2352 x 1568 pixels · CFP.
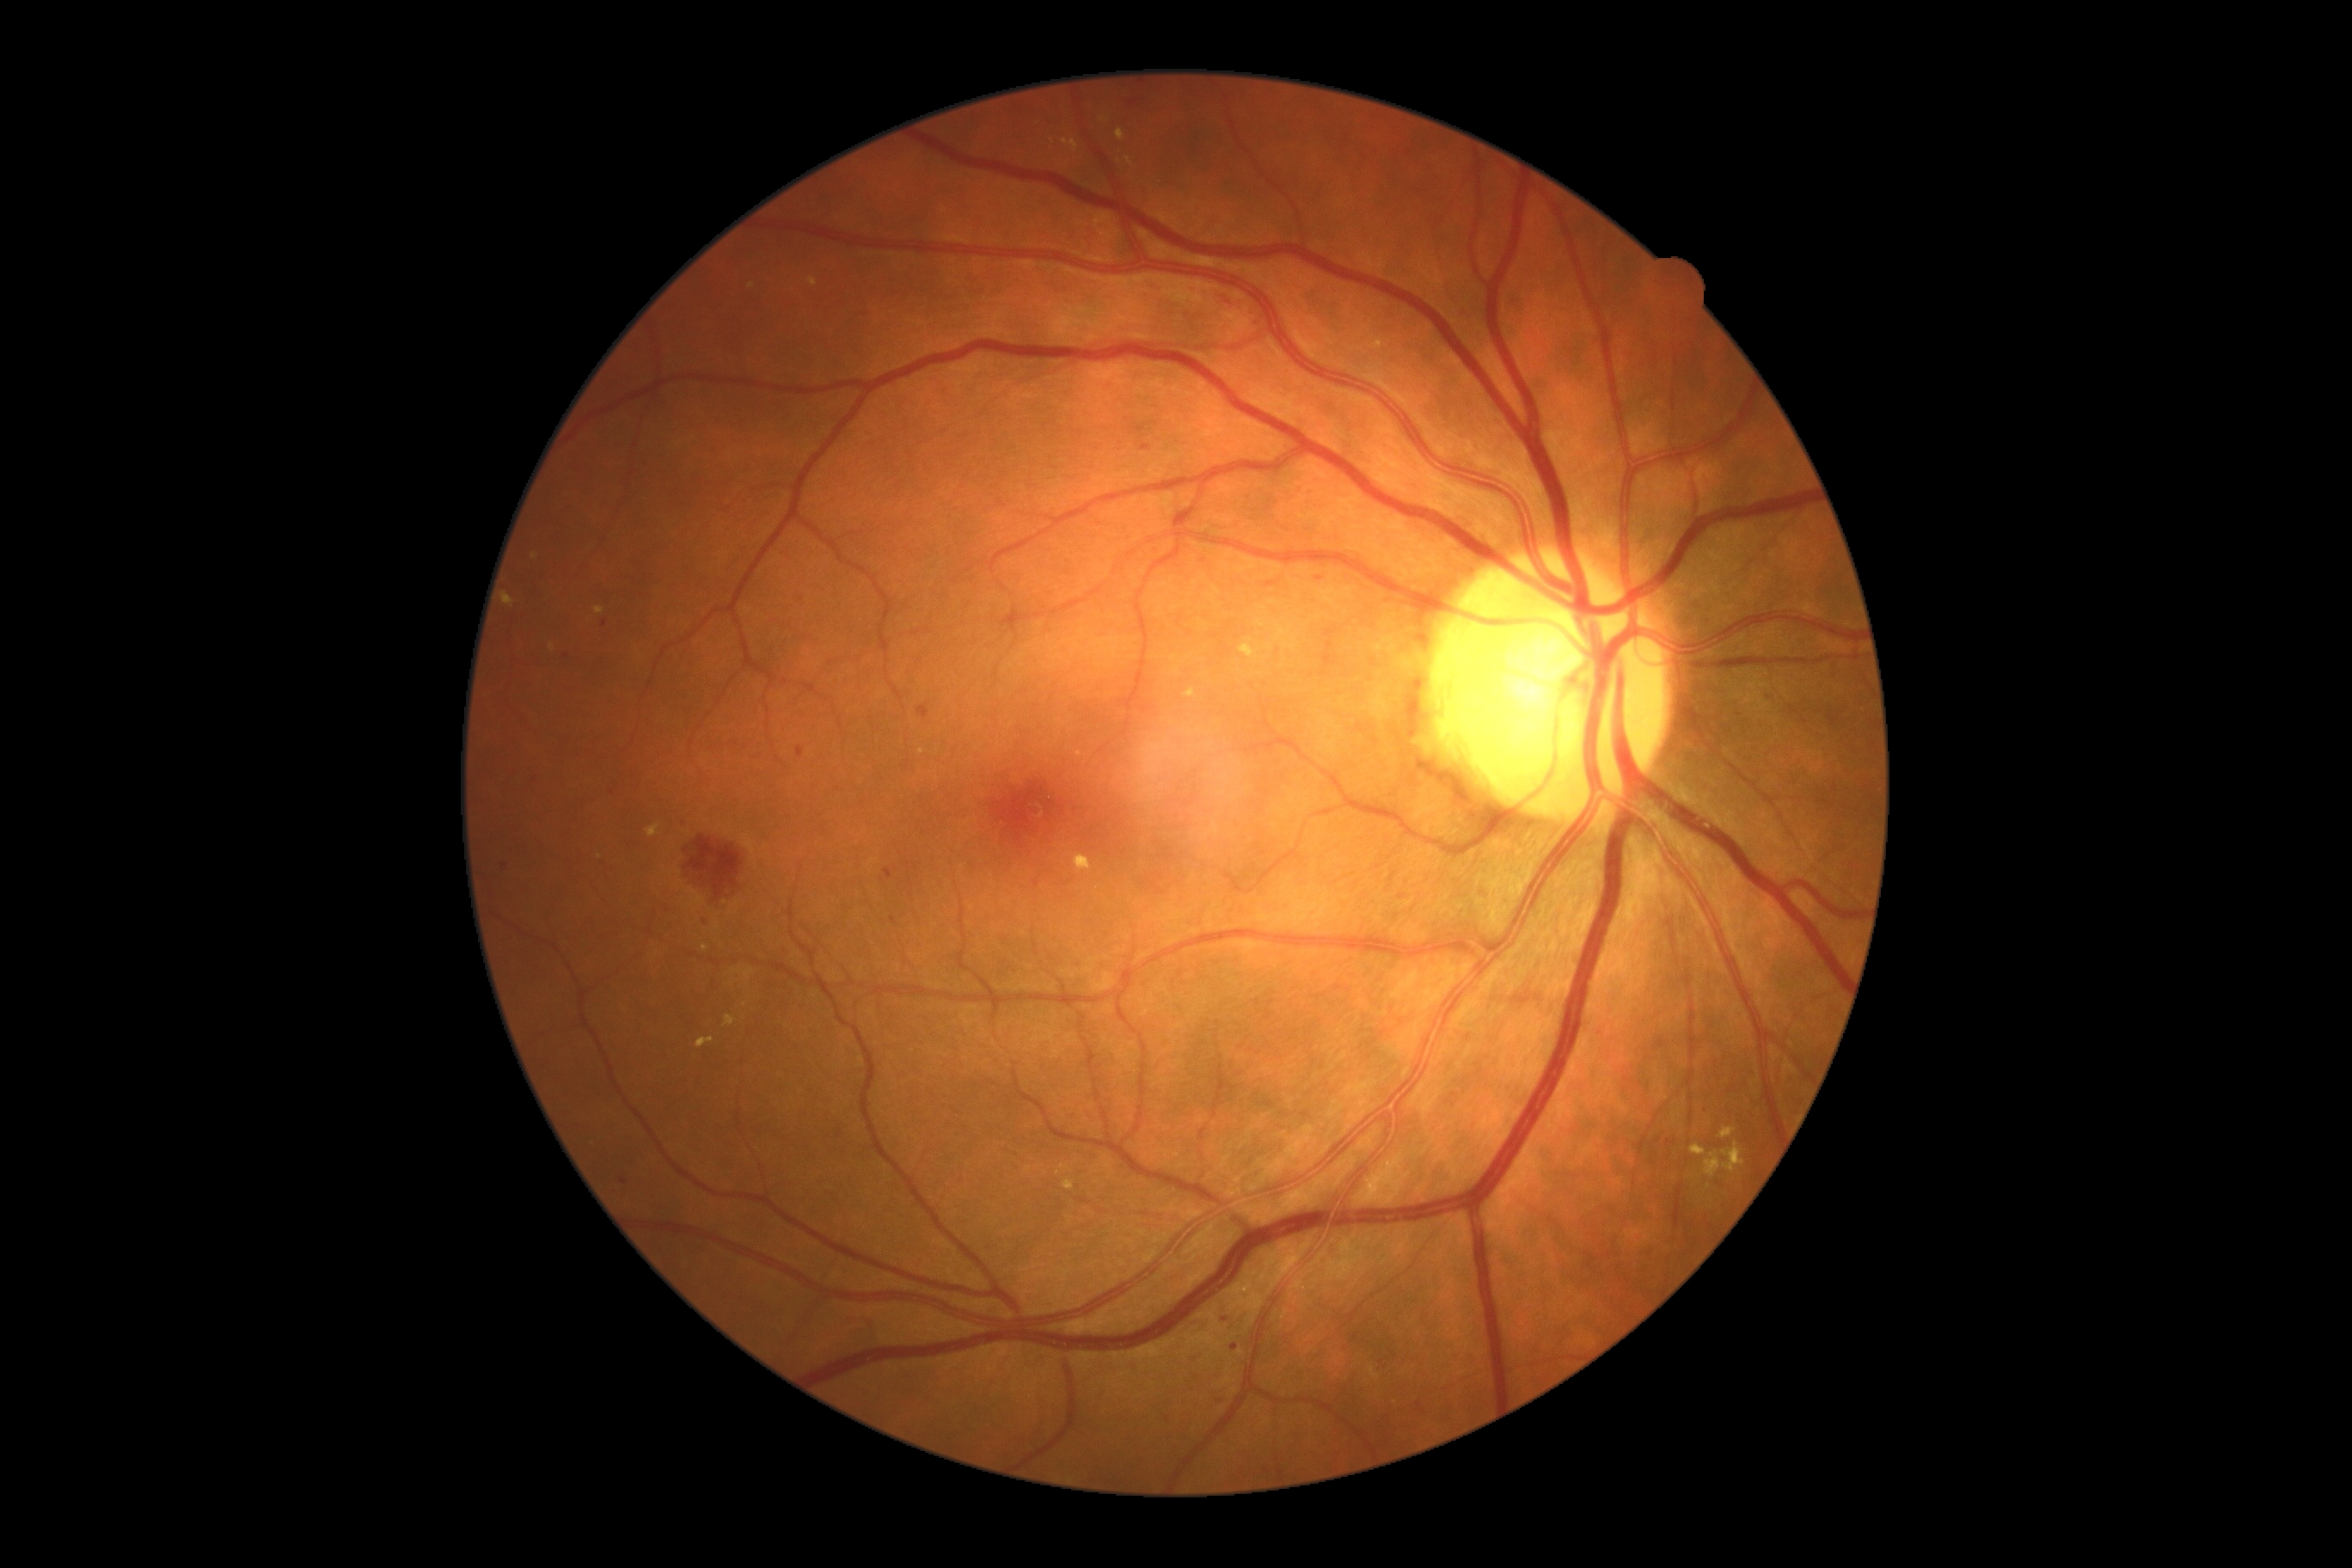
Disease class: non-proliferative diabetic retinopathy.
DR: grade 2.